Fundus photo; 1924x1556px
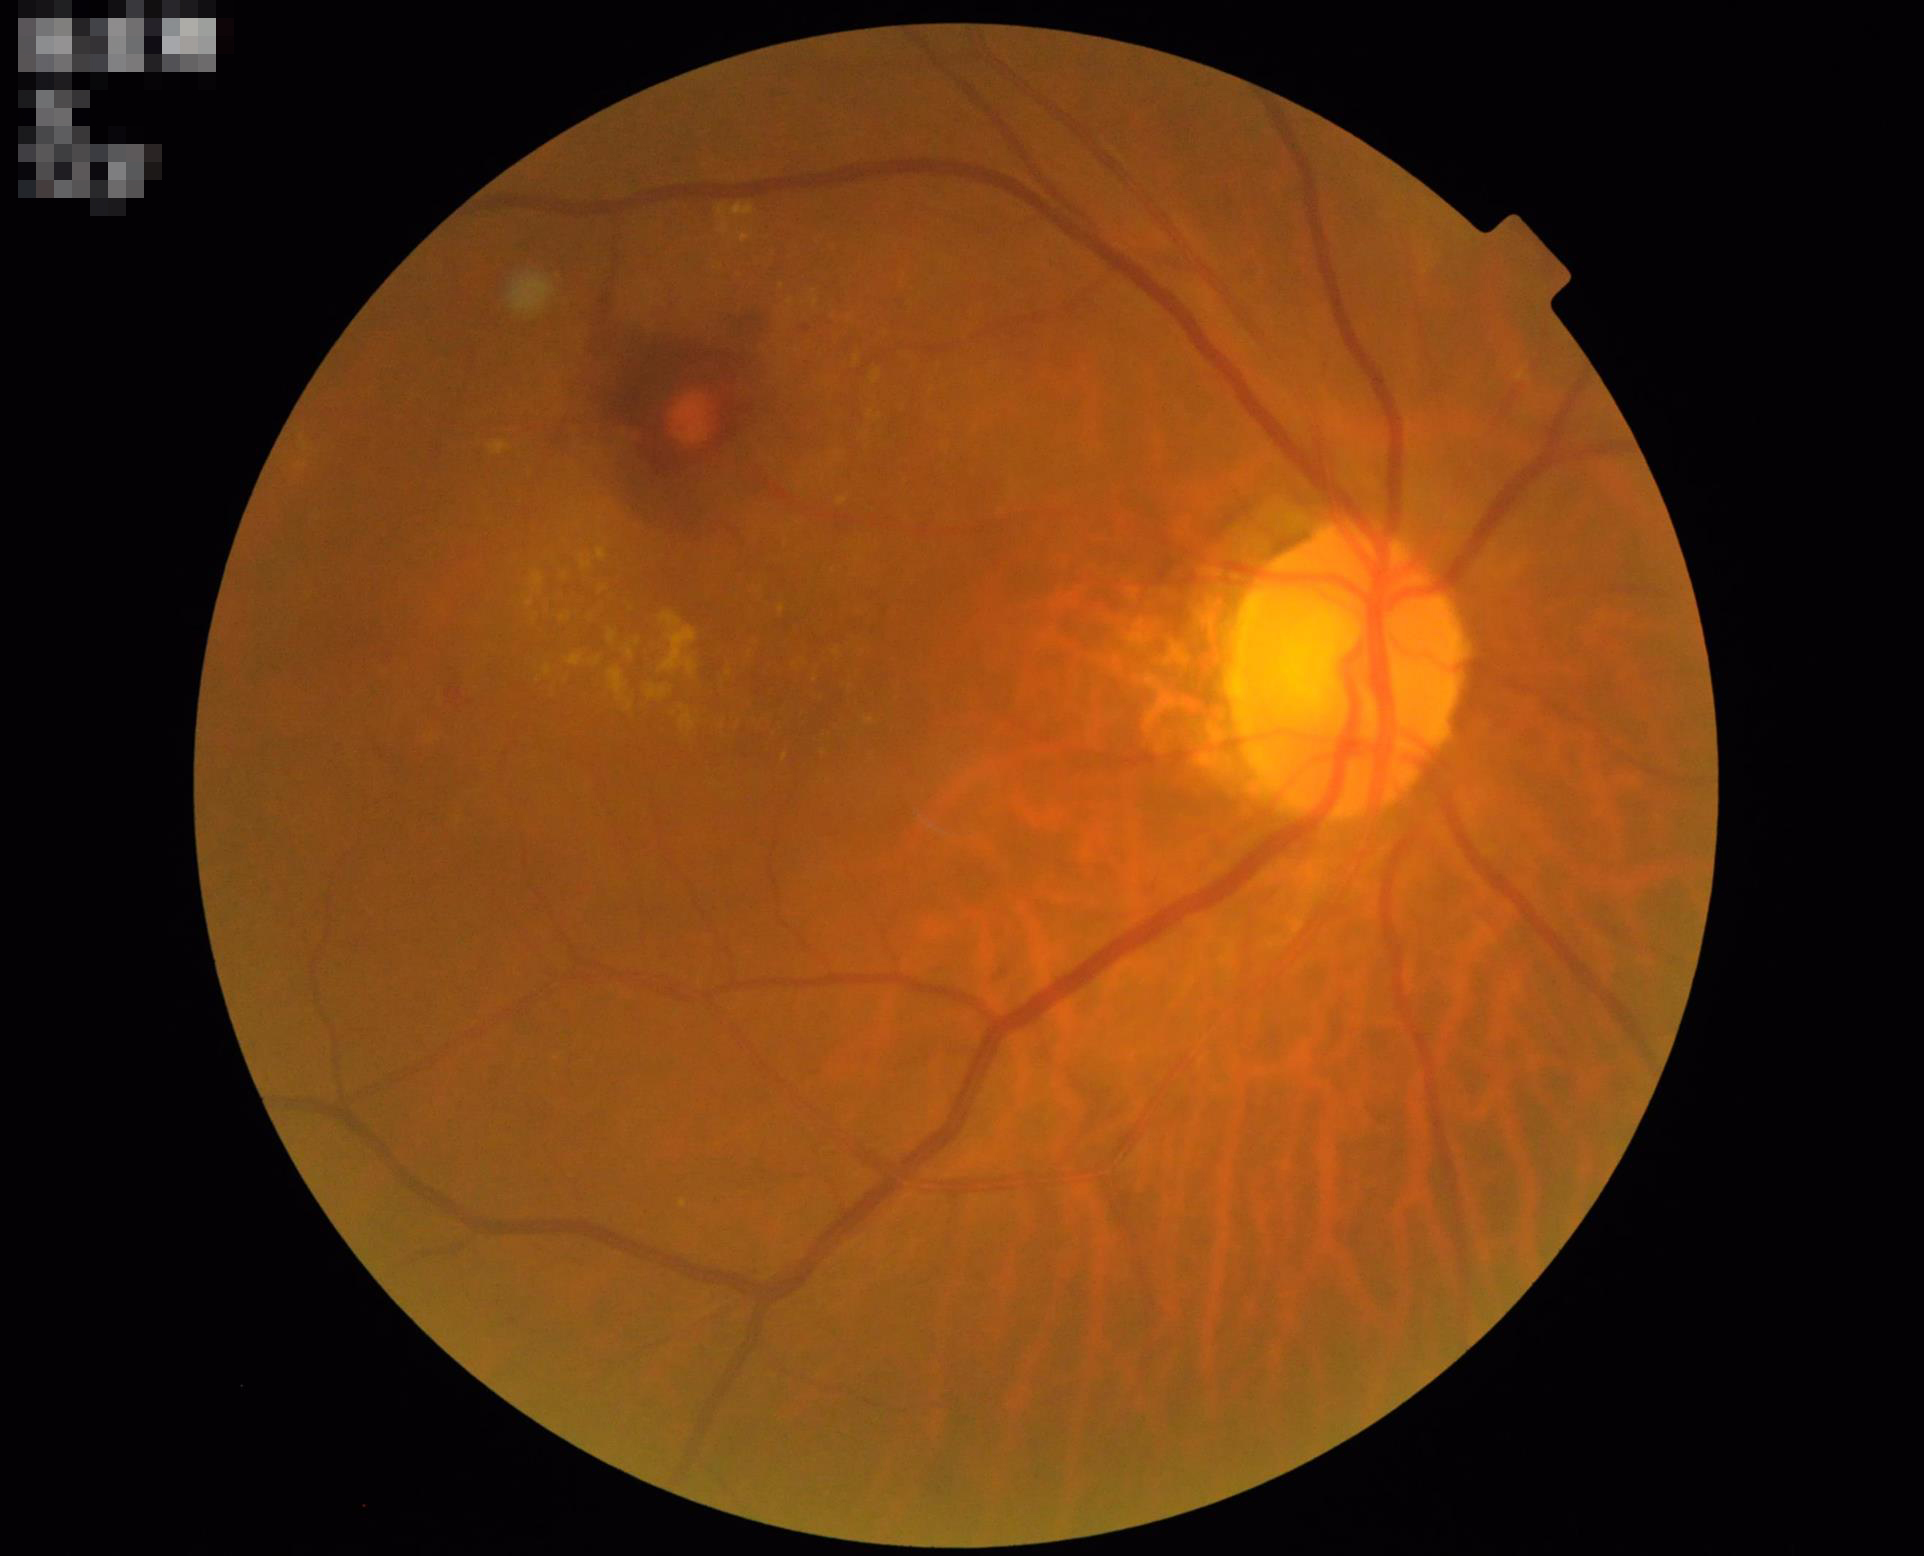

{
  "overall_quality": "good",
  "illumination": "good",
  "clarity": "clear",
  "contrast": "satisfactory"
}